Davis DR grading — 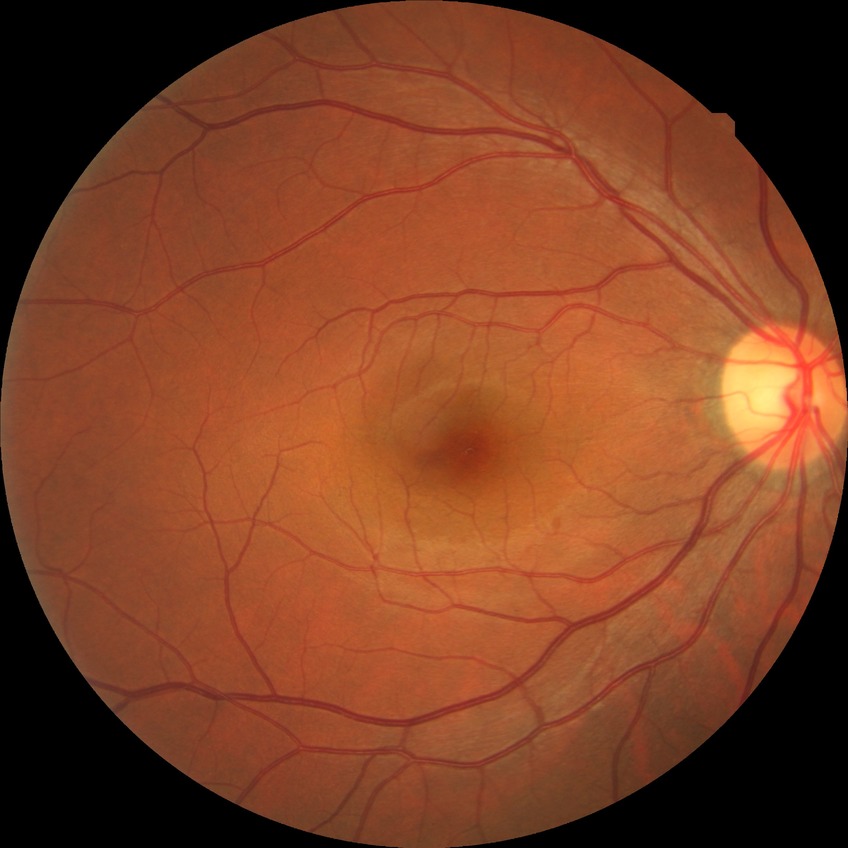
Diabetic retinopathy severity is no diabetic retinopathy.